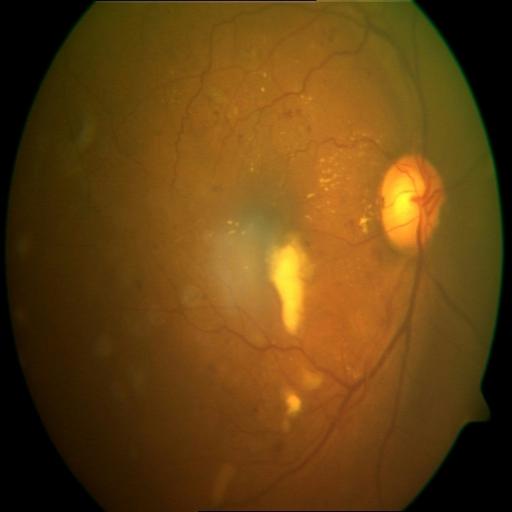 Diagnoses:
- EDN (exudation)
- HR (hemorrhagic retinopathy)